2352x1568: 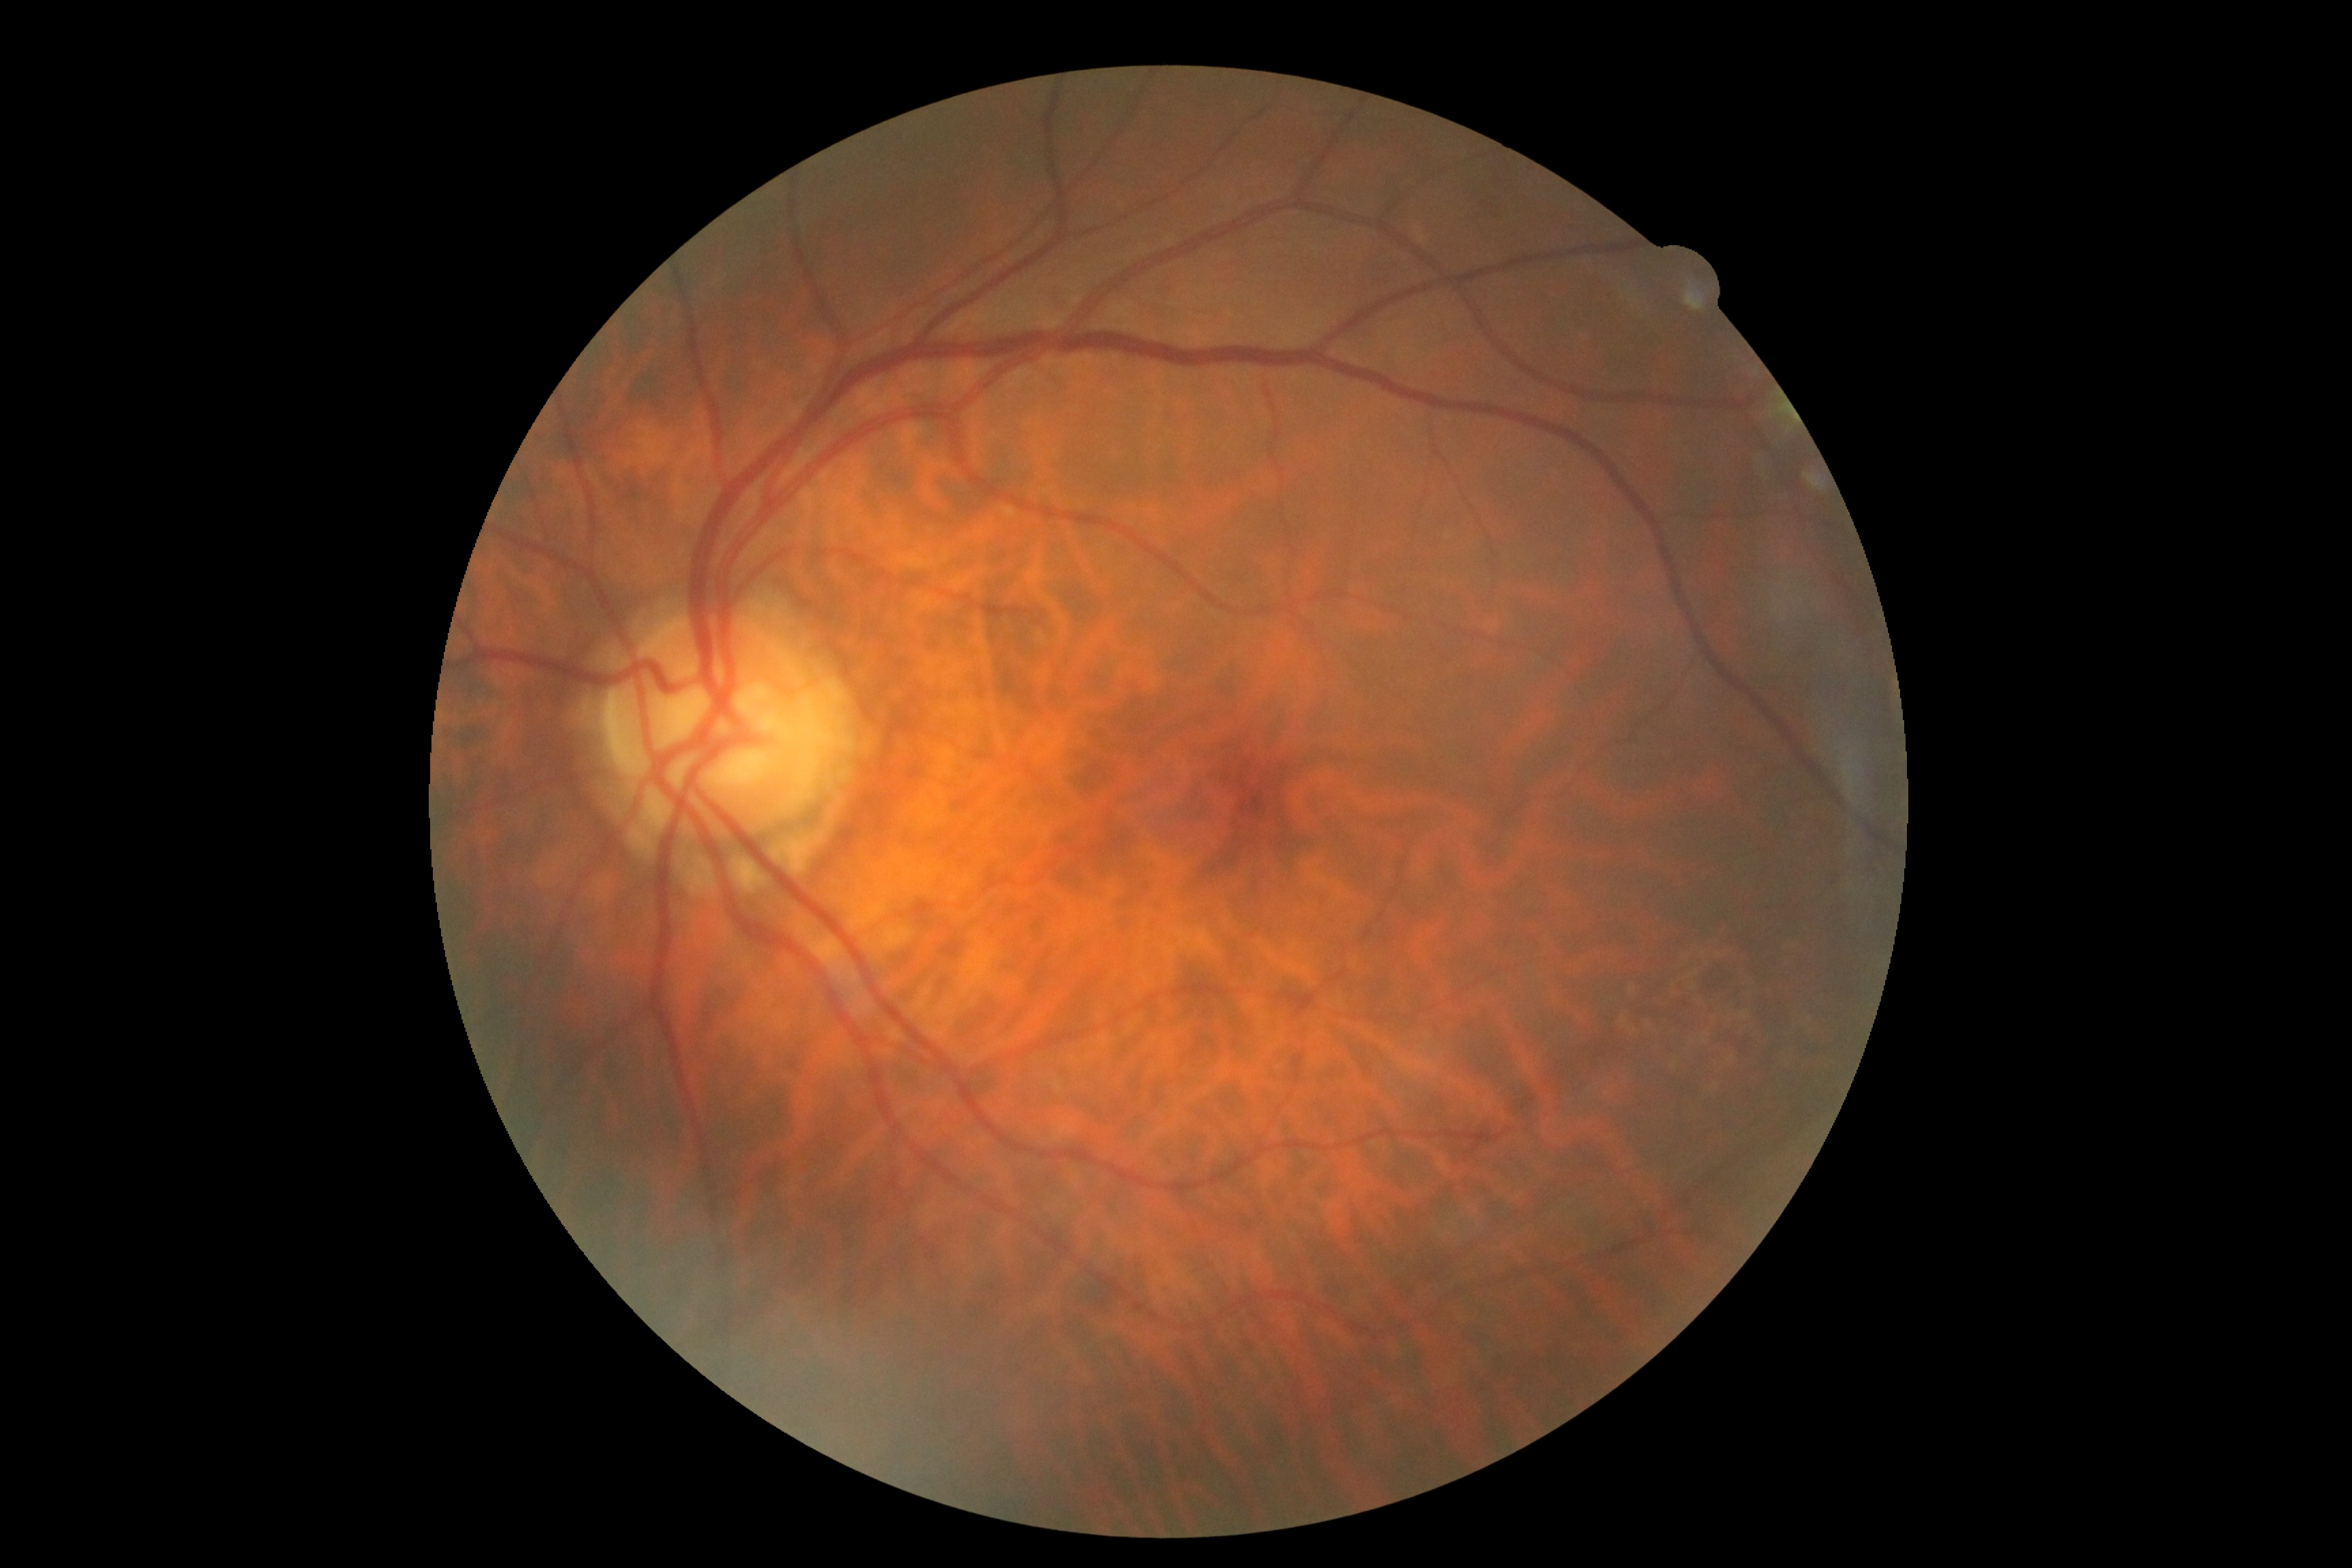 DR severity: 0/4.